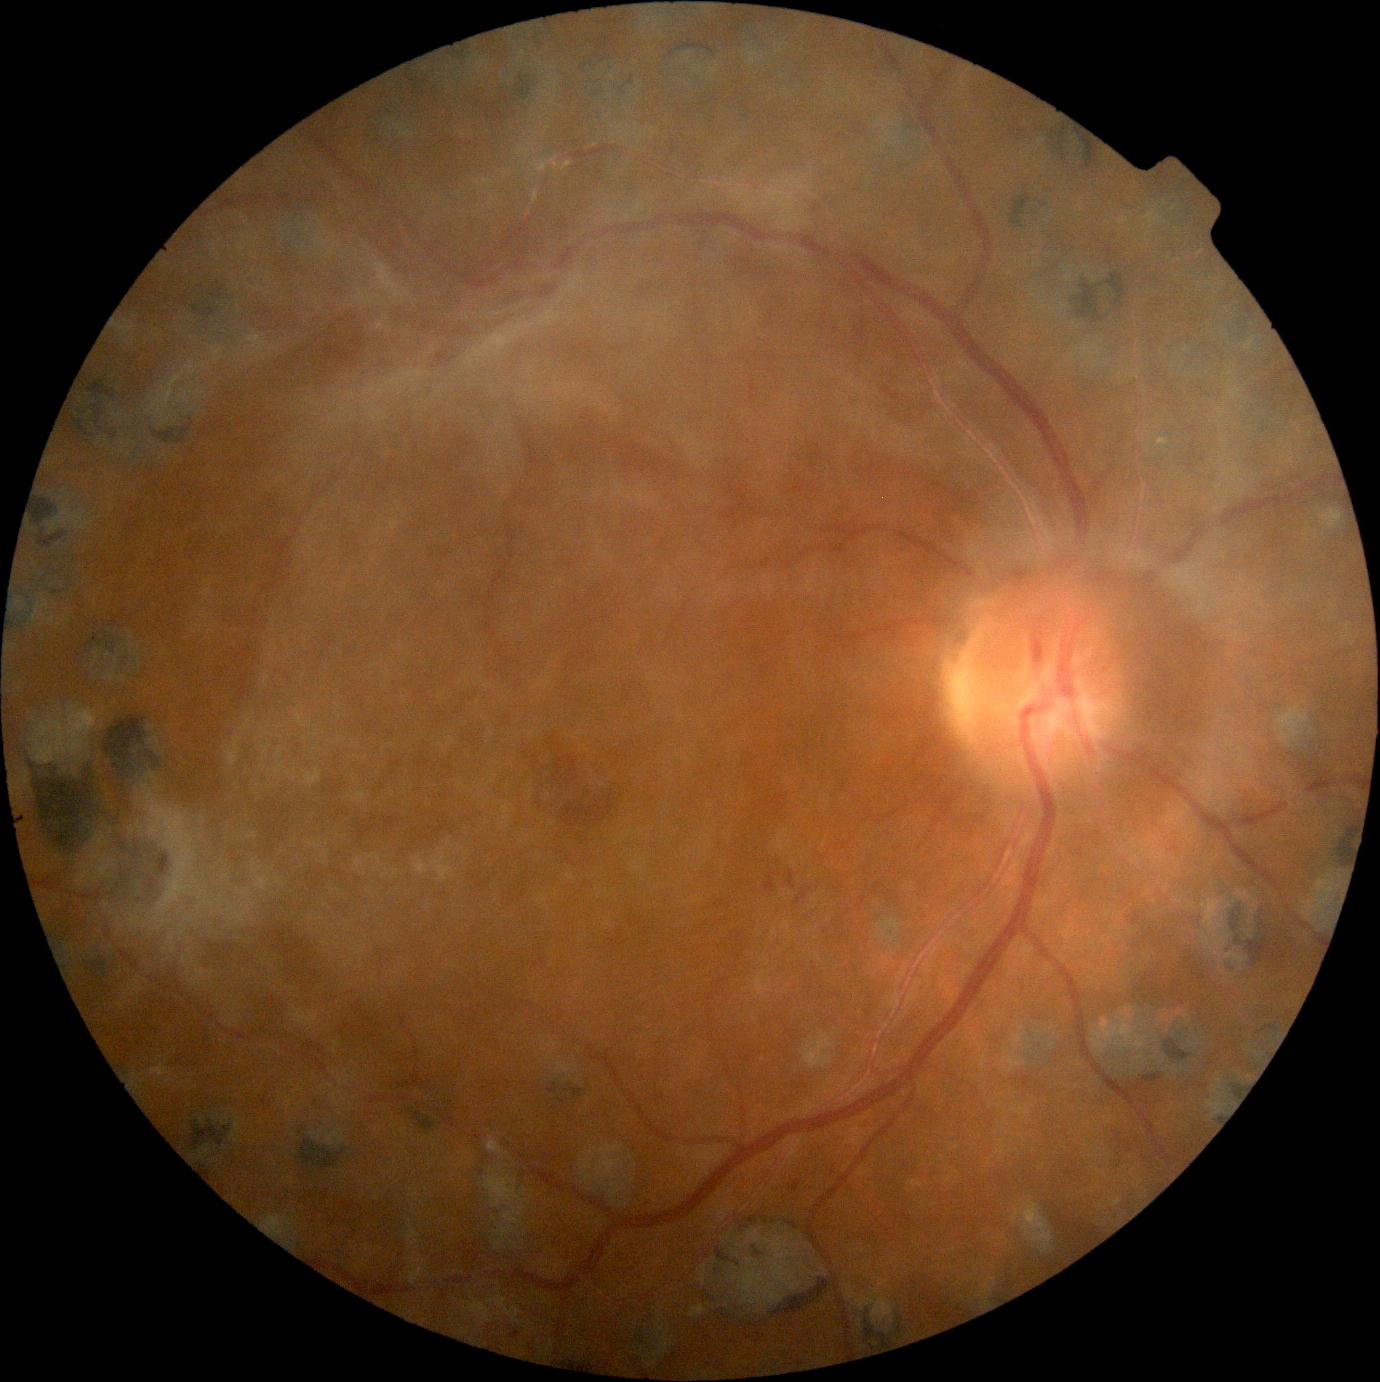
The retinopathy is classified as proliferative diabetic retinopathy. Diabetic retinopathy (DR): 4 — neovascularization and/or vitreous/pre-retinal hemorrhage.